Davis DR grading — 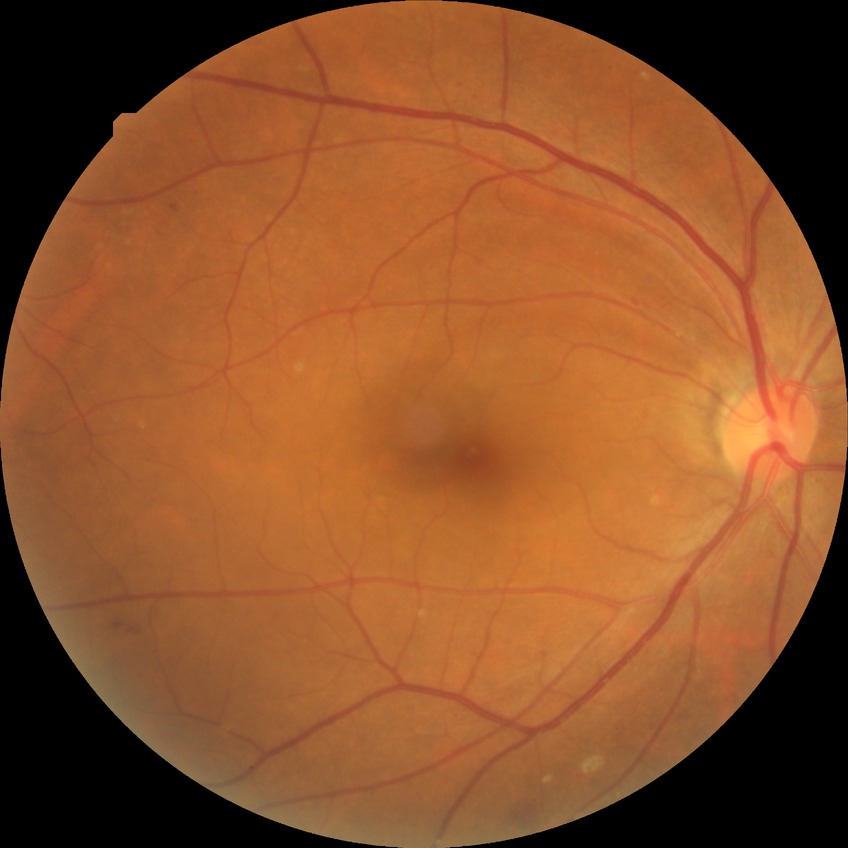 Diabetic retinopathy stage is simple diabetic retinopathy.